45 degree fundus photograph, modified Davis grading, nonmydriatic fundus photograph, posterior pole photograph — 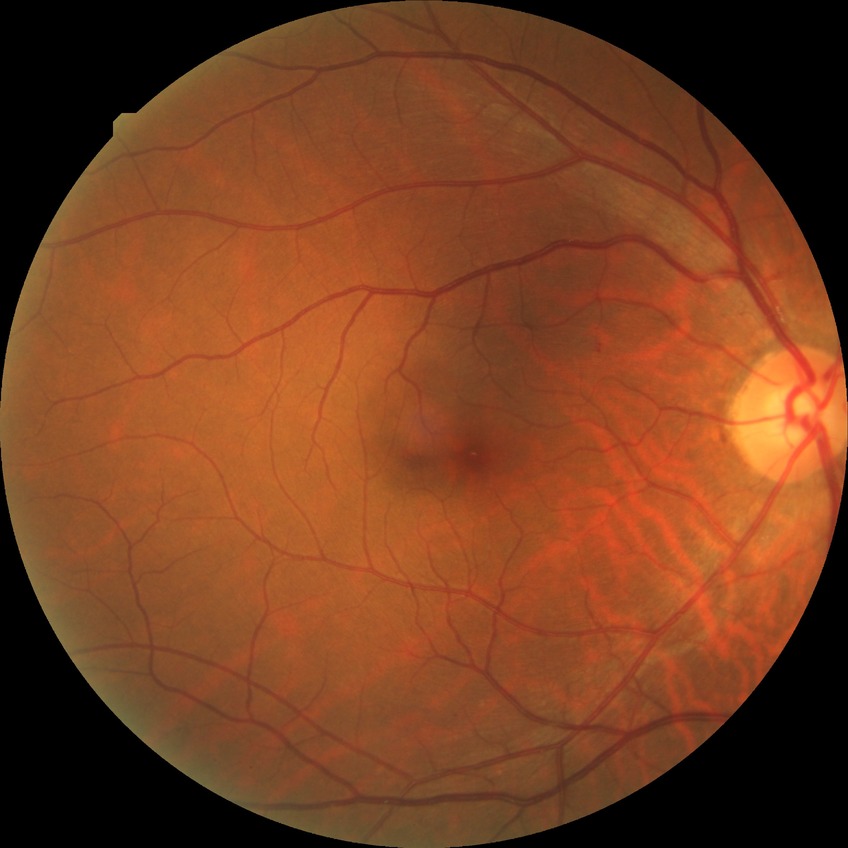 Diabetic retinopathy (DR) is simple diabetic retinopathy (SDR). The retinopathy is classified as non-proliferative diabetic retinopathy.